848x848
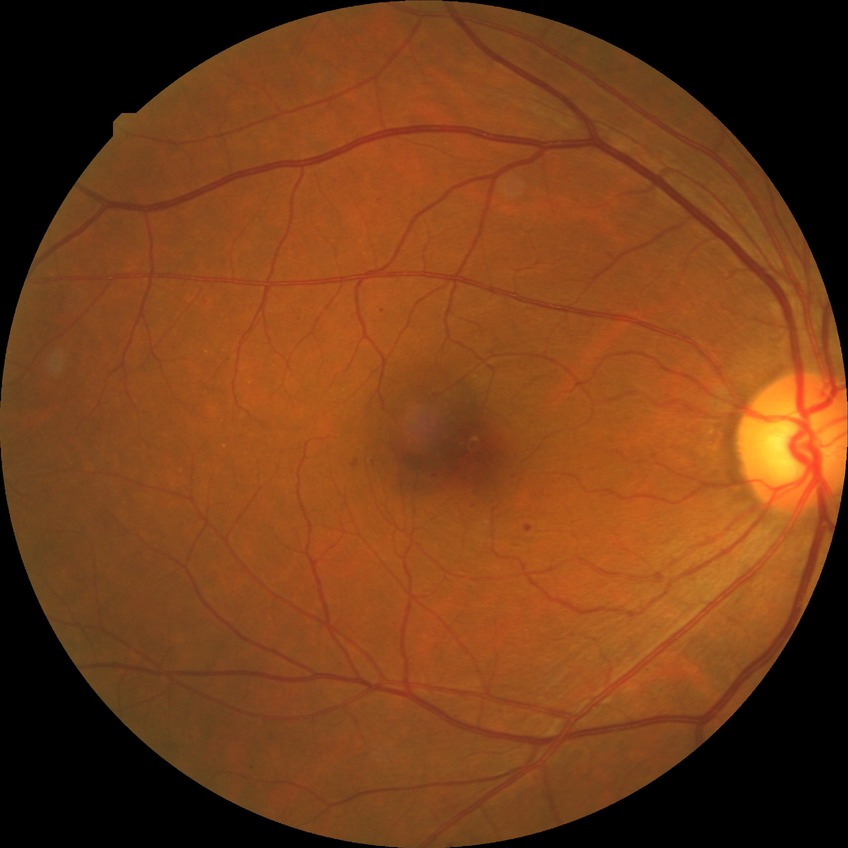
Davis grade is SDR.